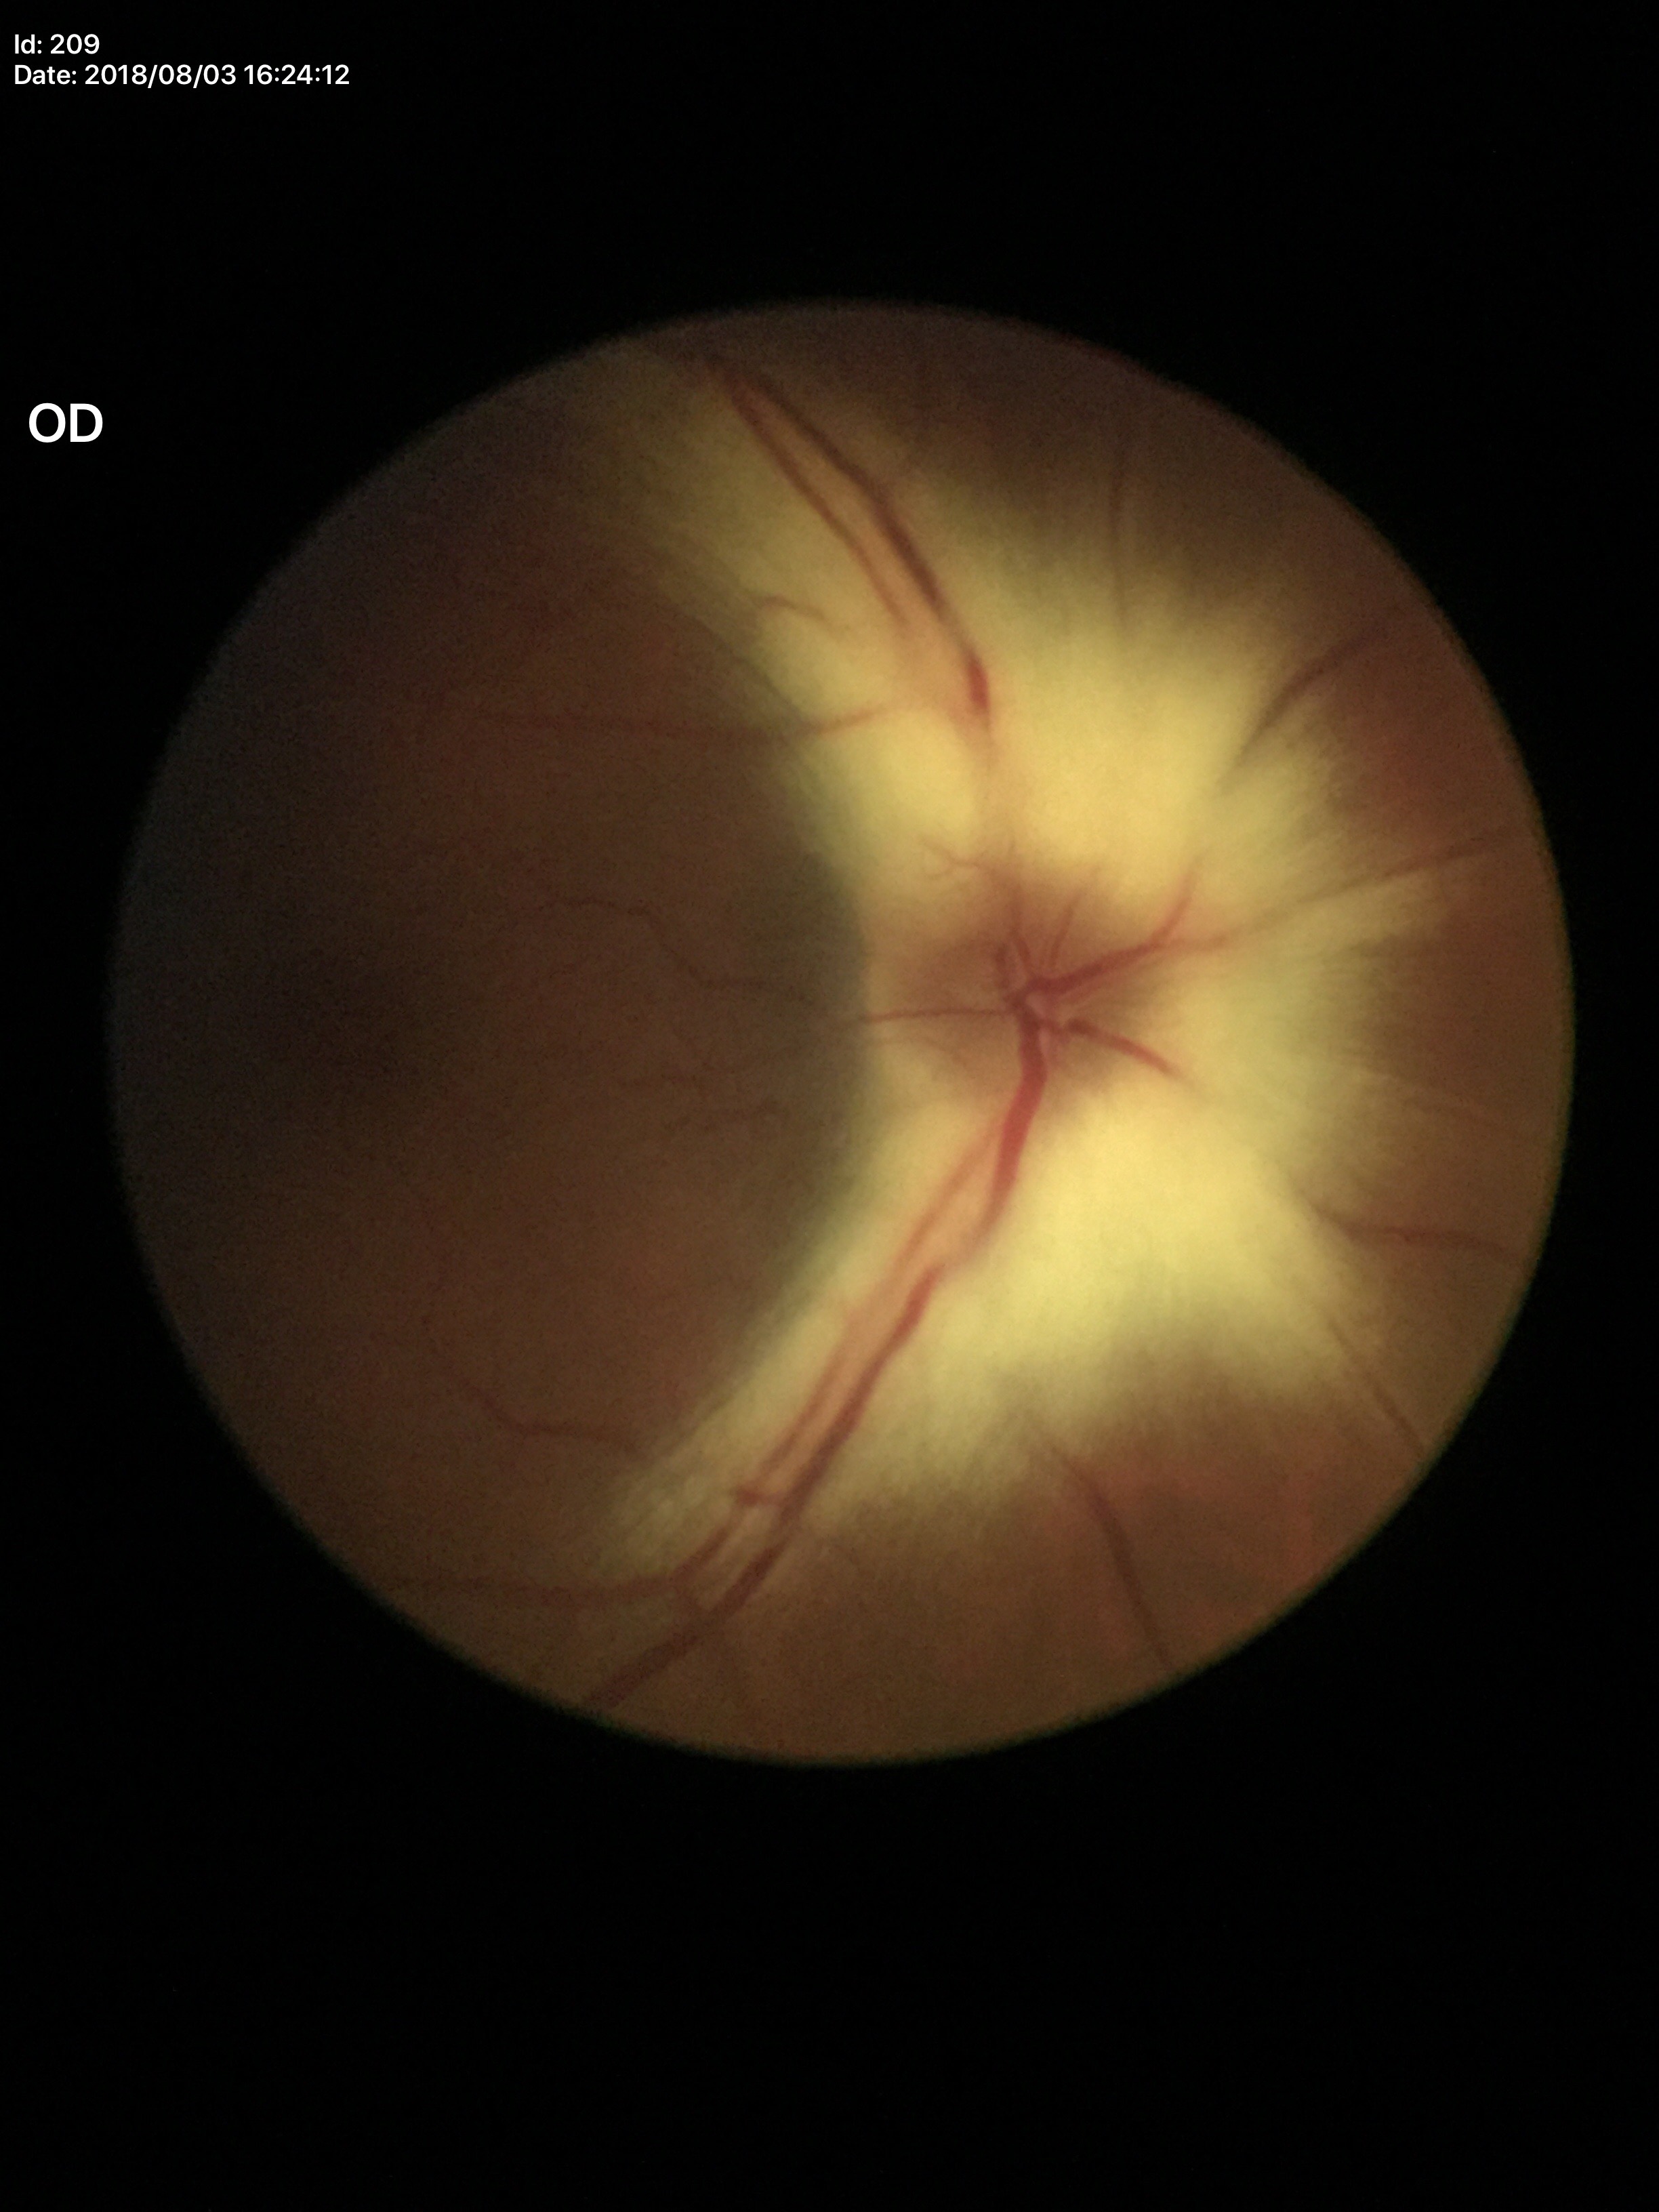 Glaucoma impression: negative
horizontal CDR: 0.31
vertical cup-to-disc ratio: 0.38